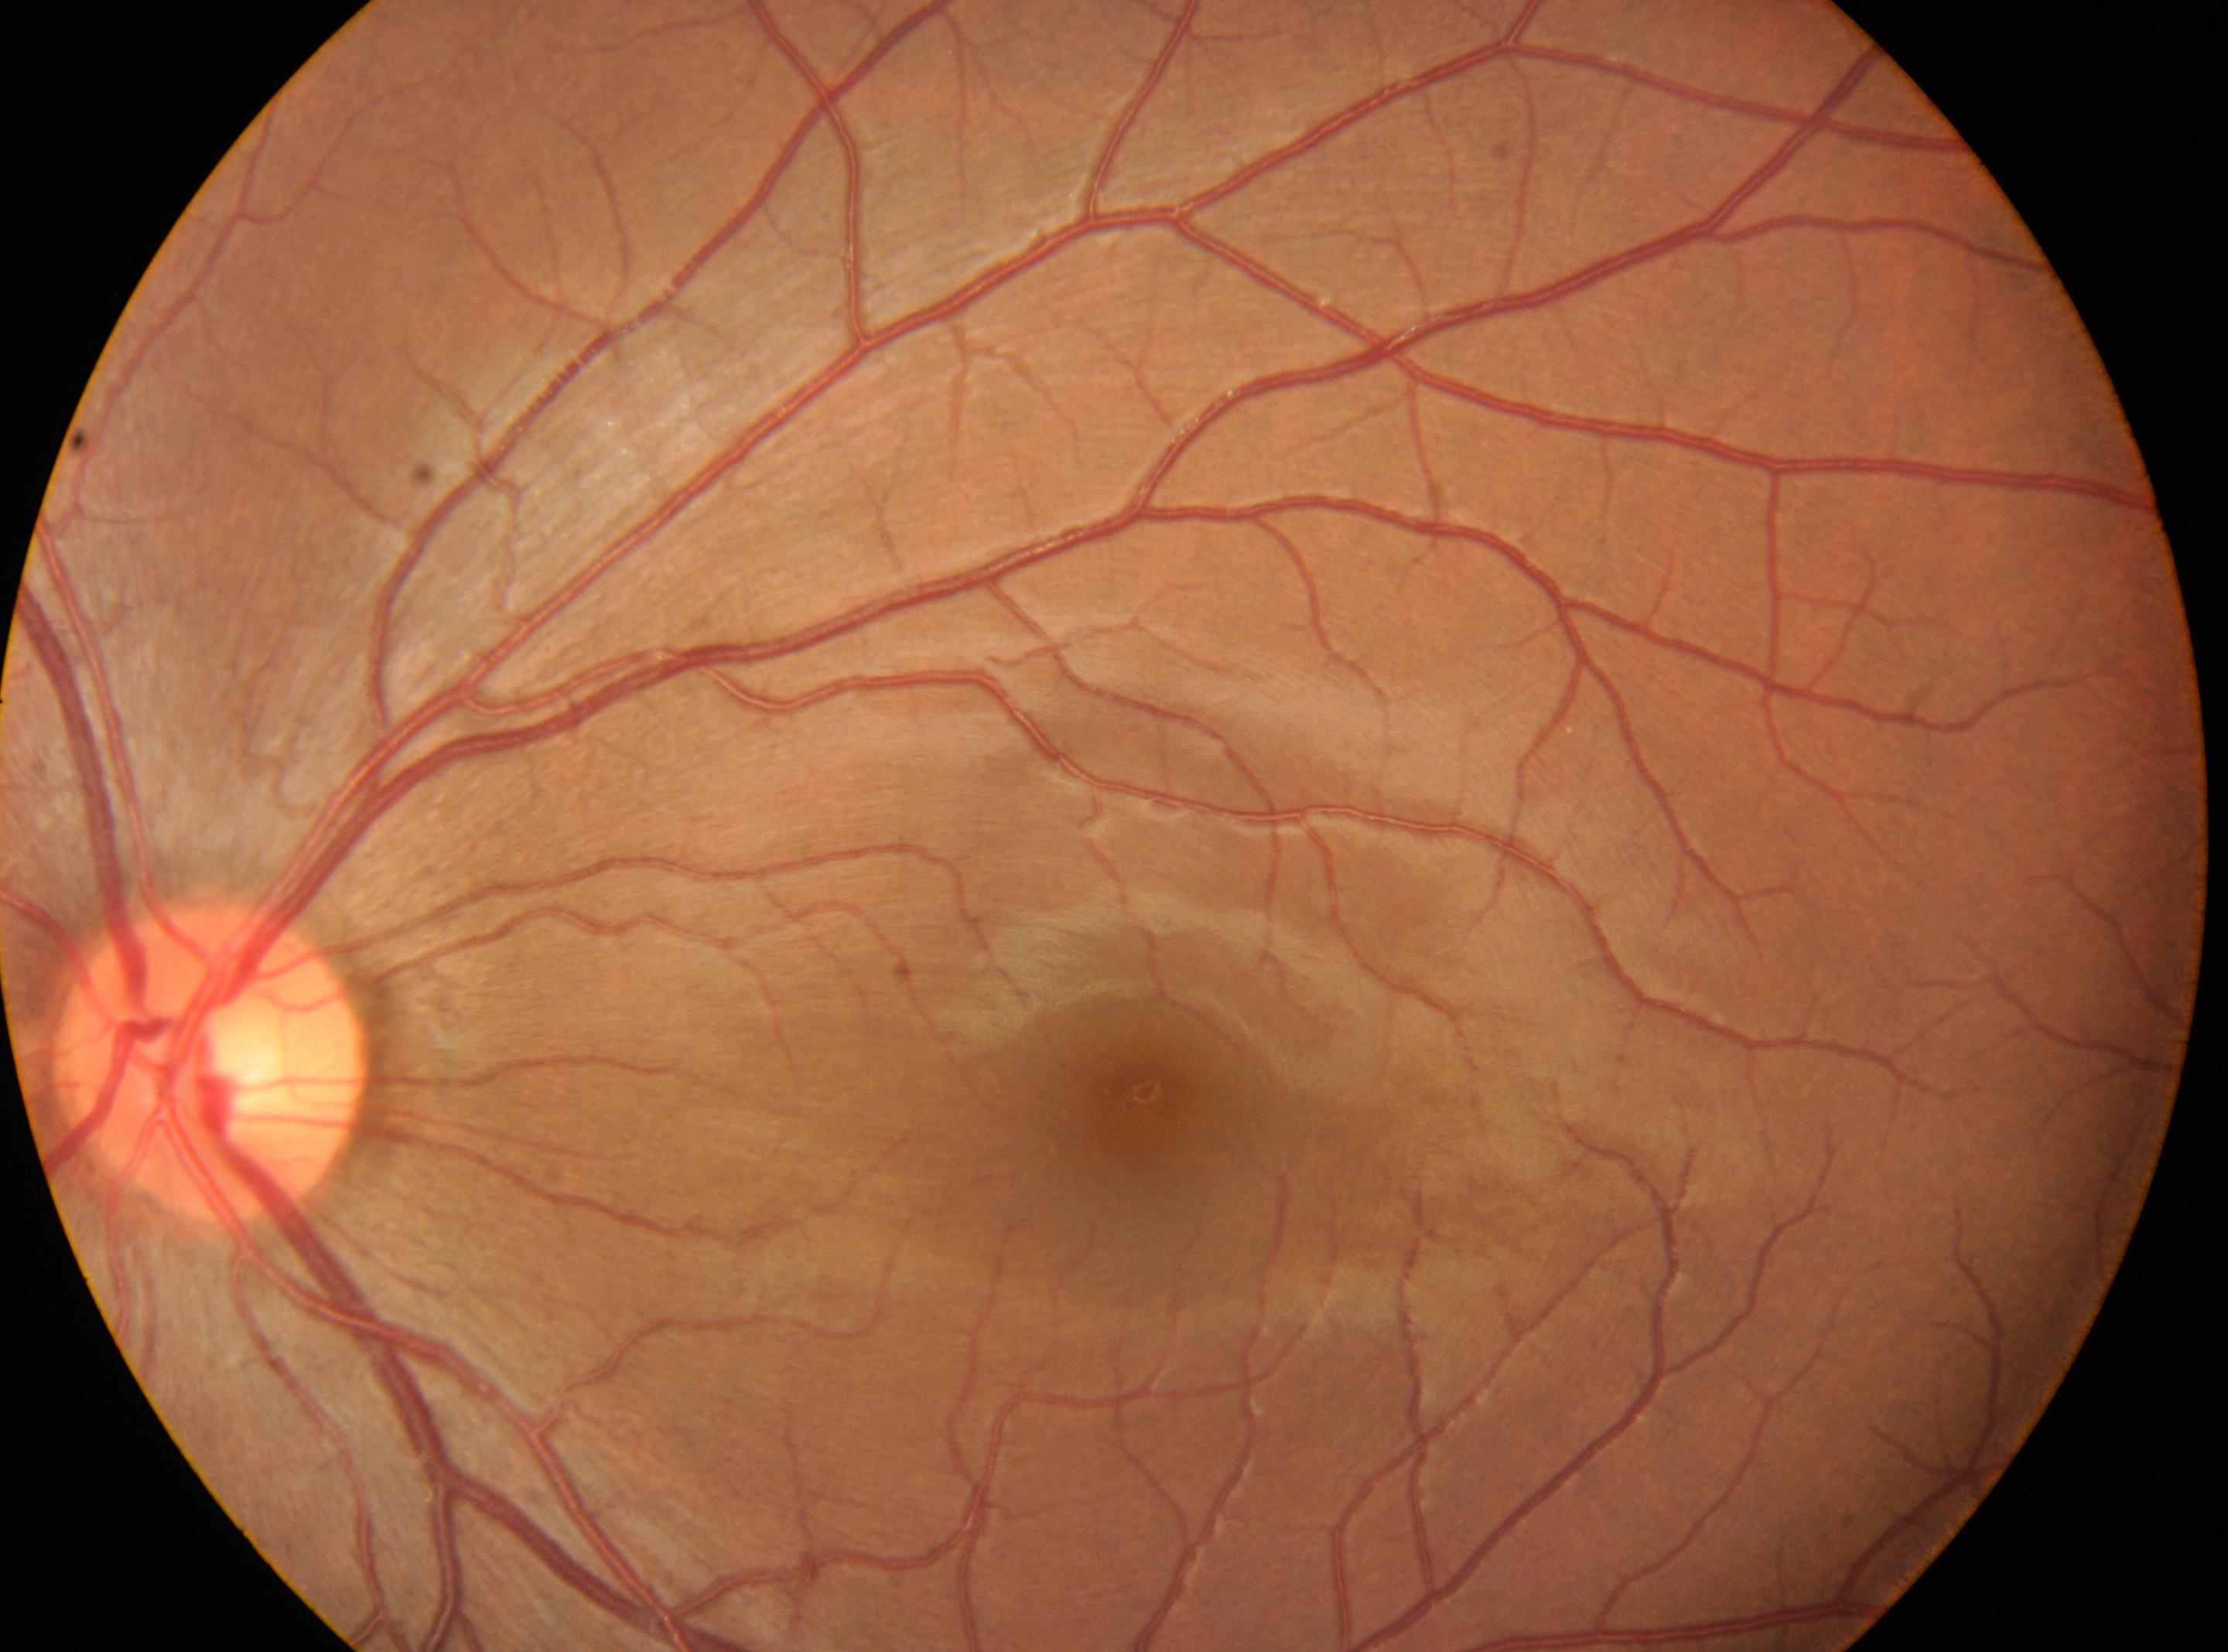 Eye: OS.
Macular center: (1145,1109).
Optic disc located at (211,1064).
DR stage is 0/4.